NIDEK AFC-230 fundus camera
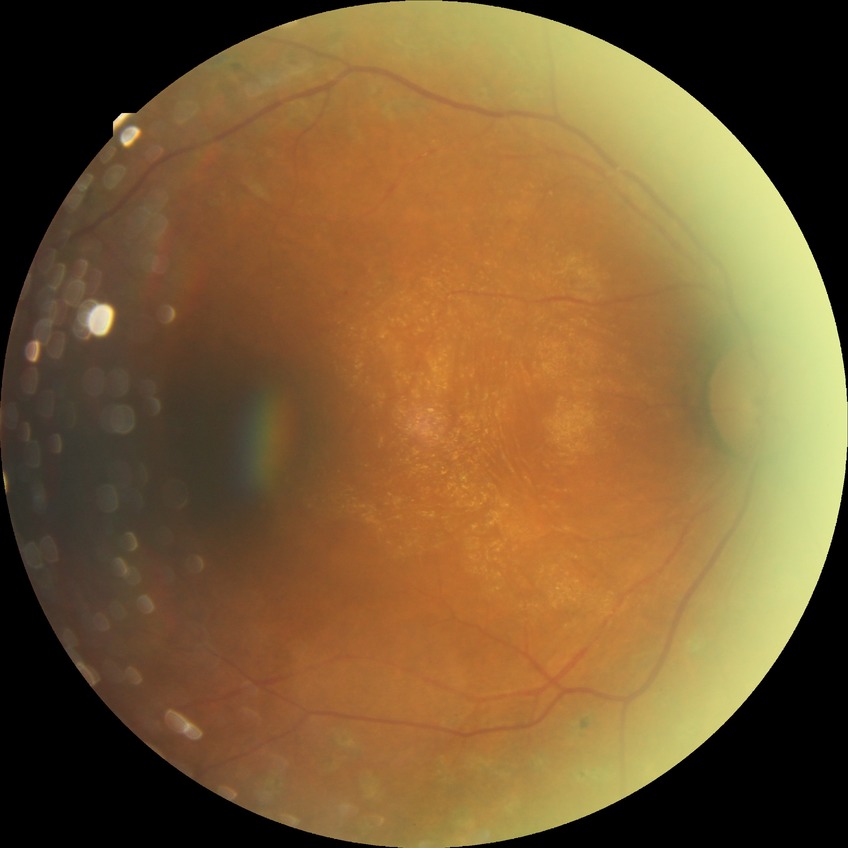 Assessment:
– diabetic retinopathy (DR) — PDR (proliferative diabetic retinopathy)